Disc-centered fundus crop
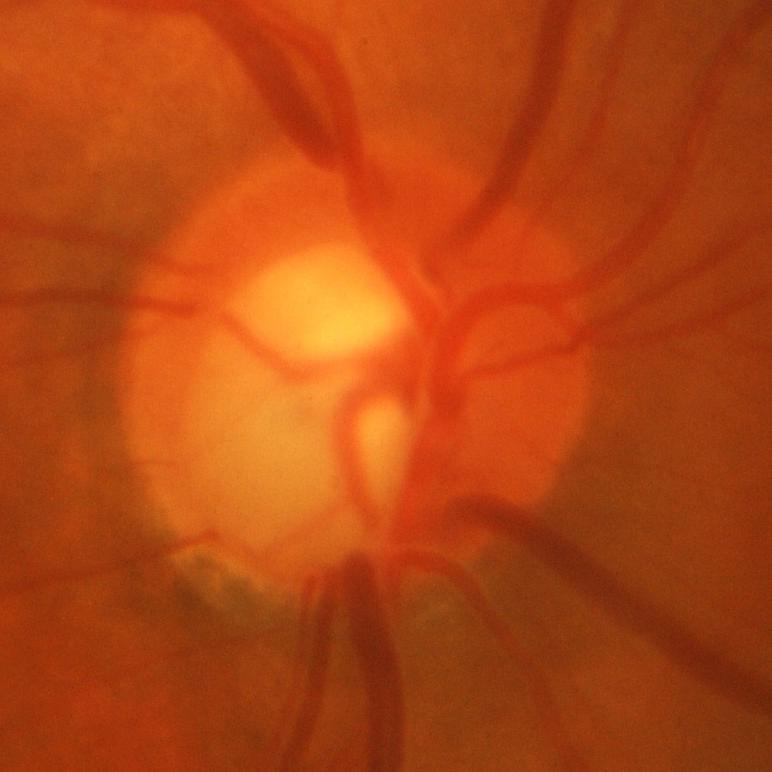

Glaucomatous changes are present. Glaucoma diagnosis = evidence of glaucoma.